45 degree fundus photograph: 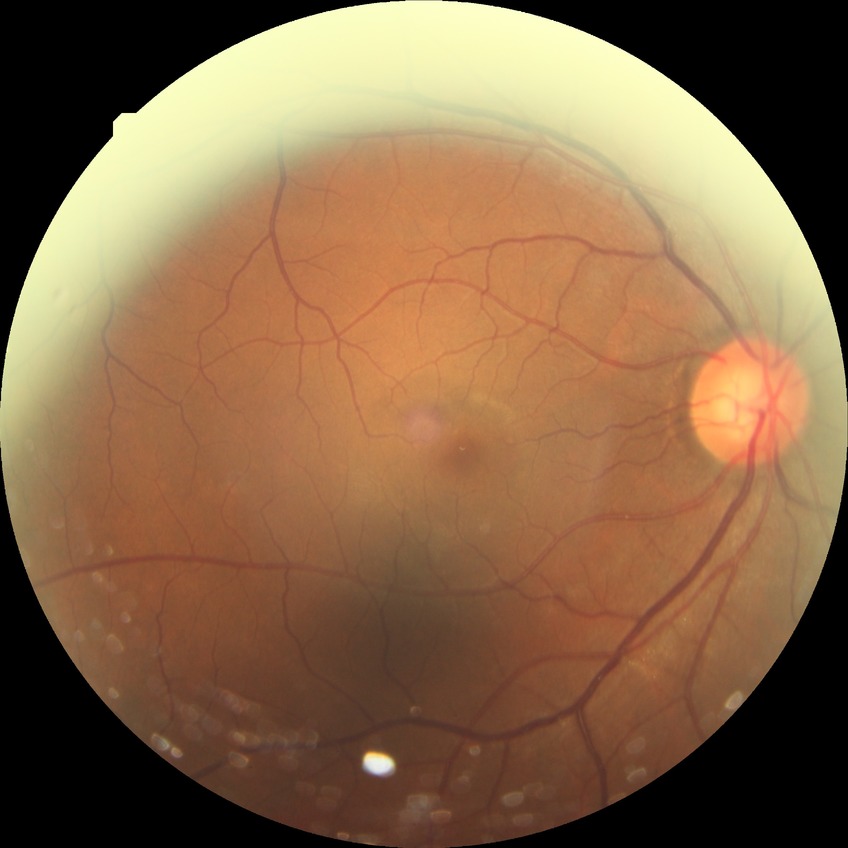
Retinopathy stage: no diabetic retinopathy.